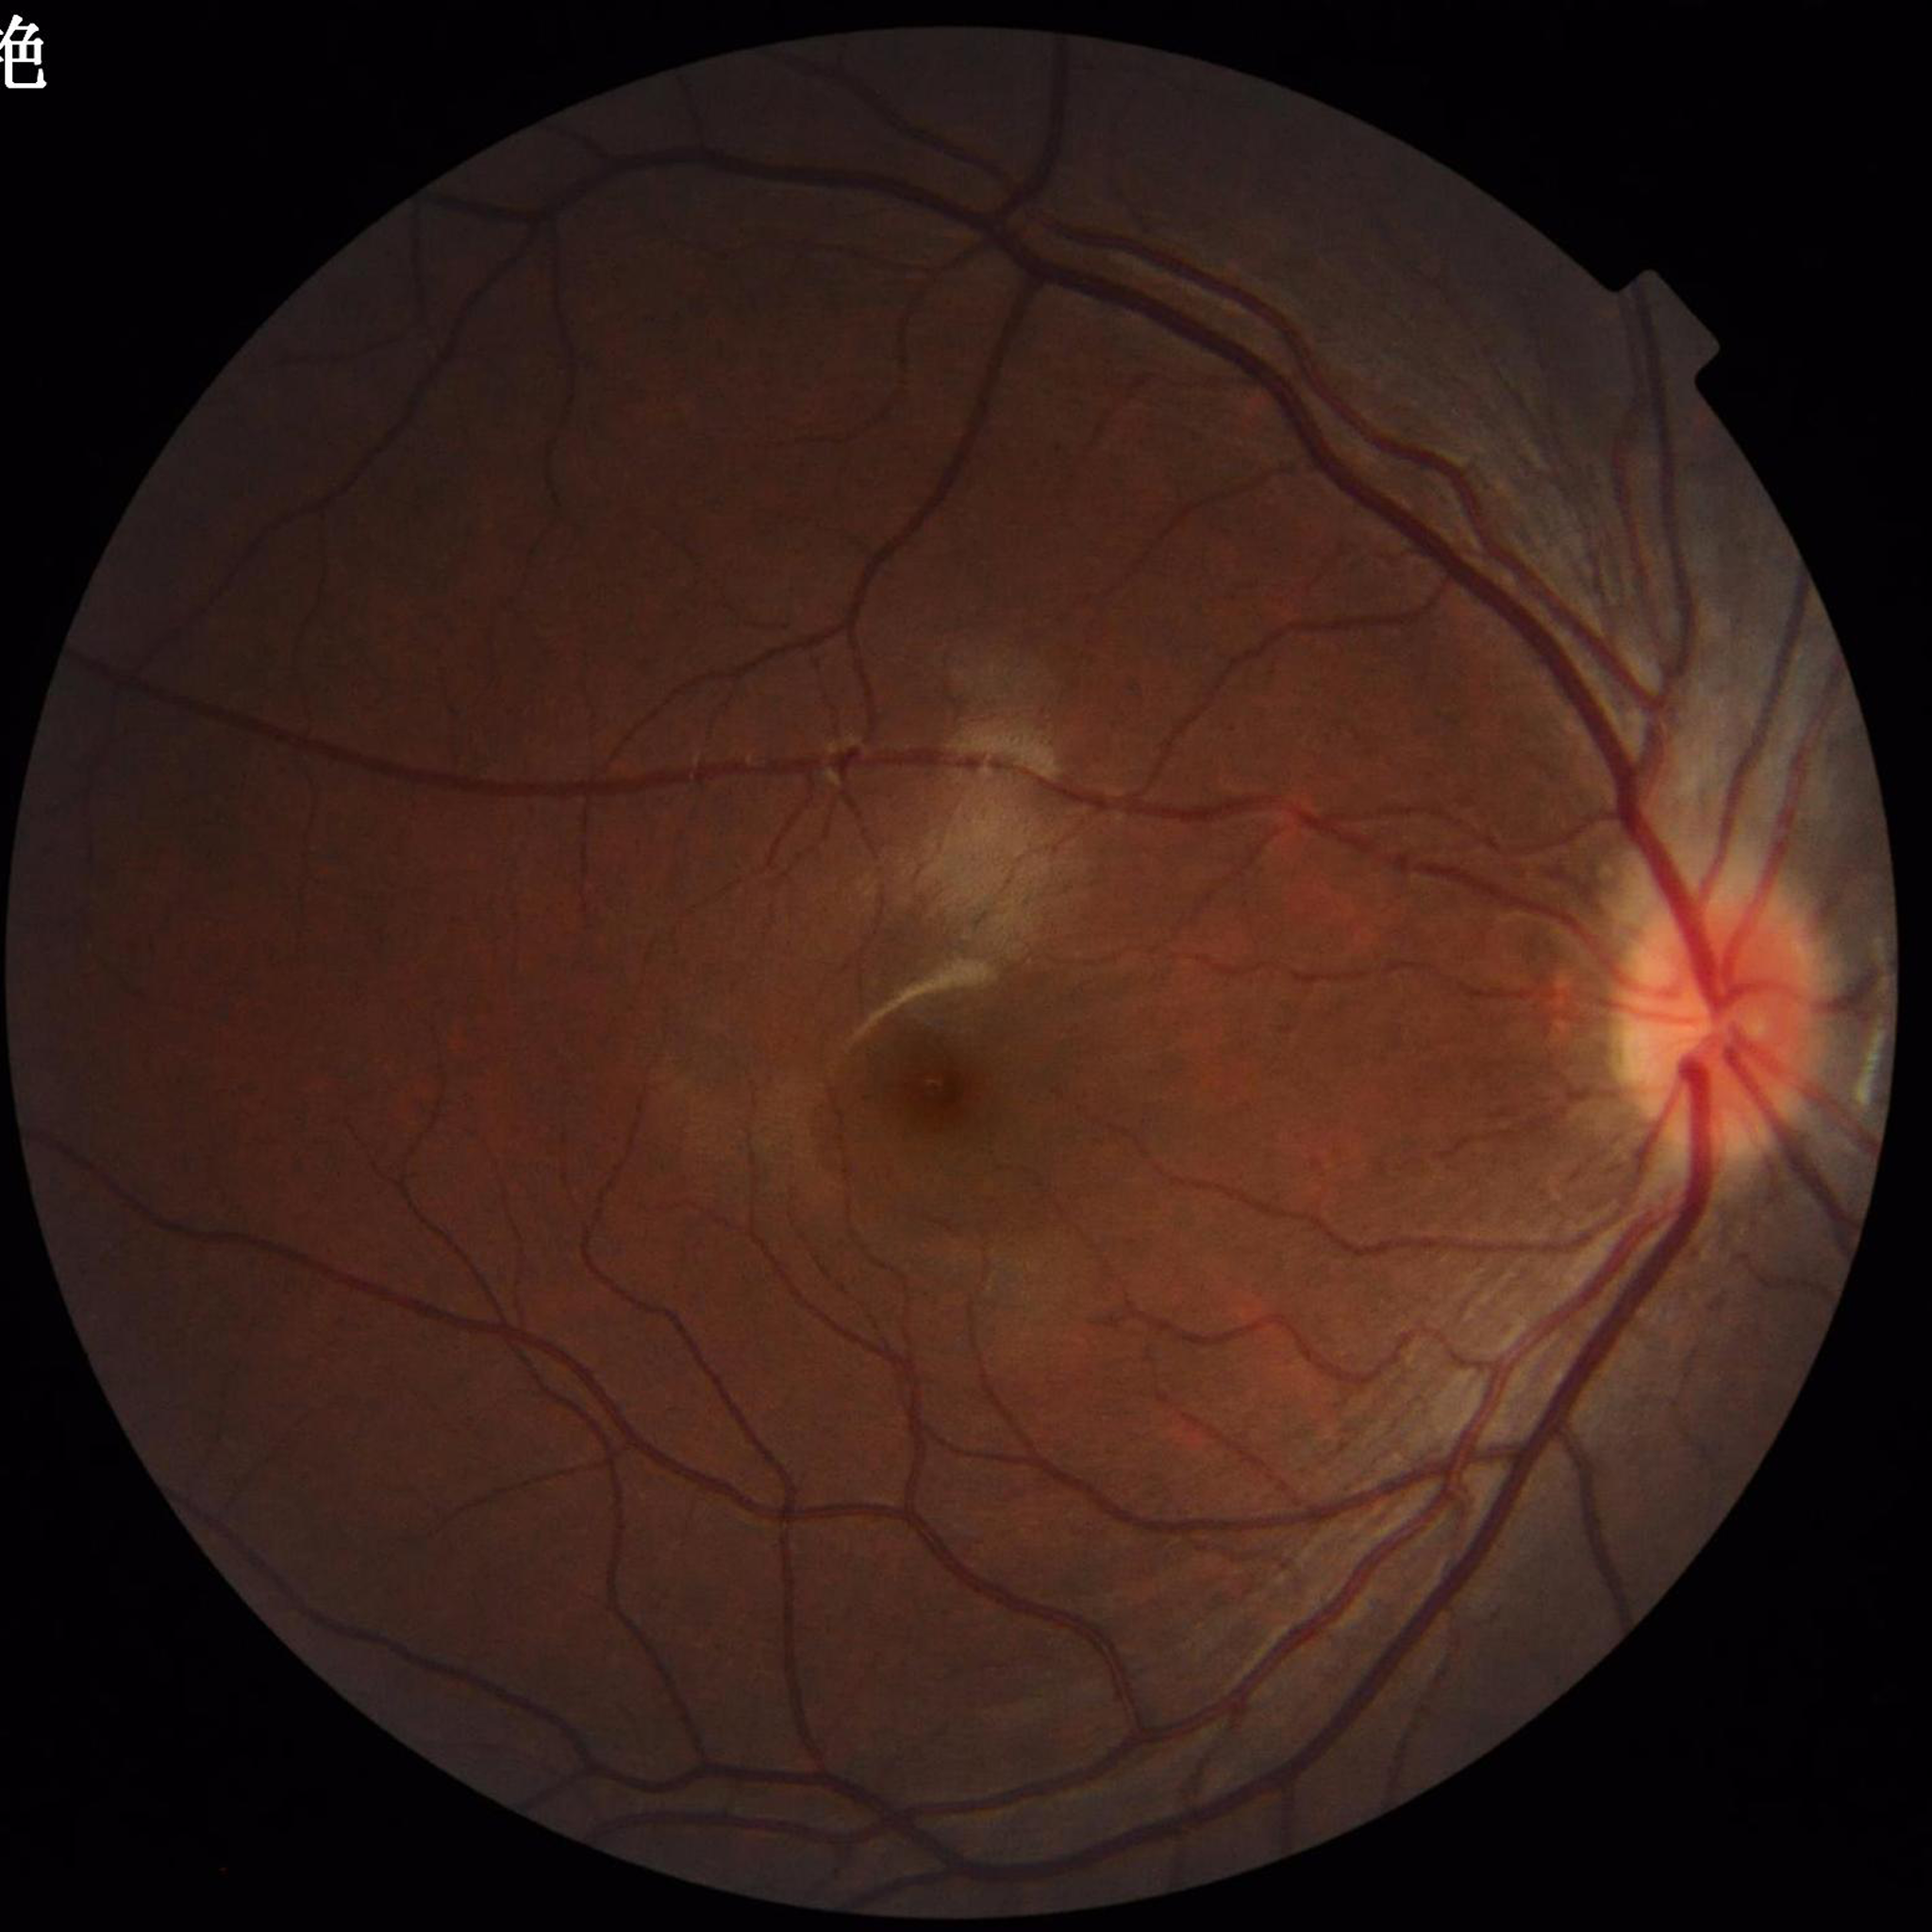

Quality assessment: no quality issues identified; Disease: control (no AMD/DR/glaucoma).